Captured after pupil dilation, acquired with a Topcon TRC-50DX
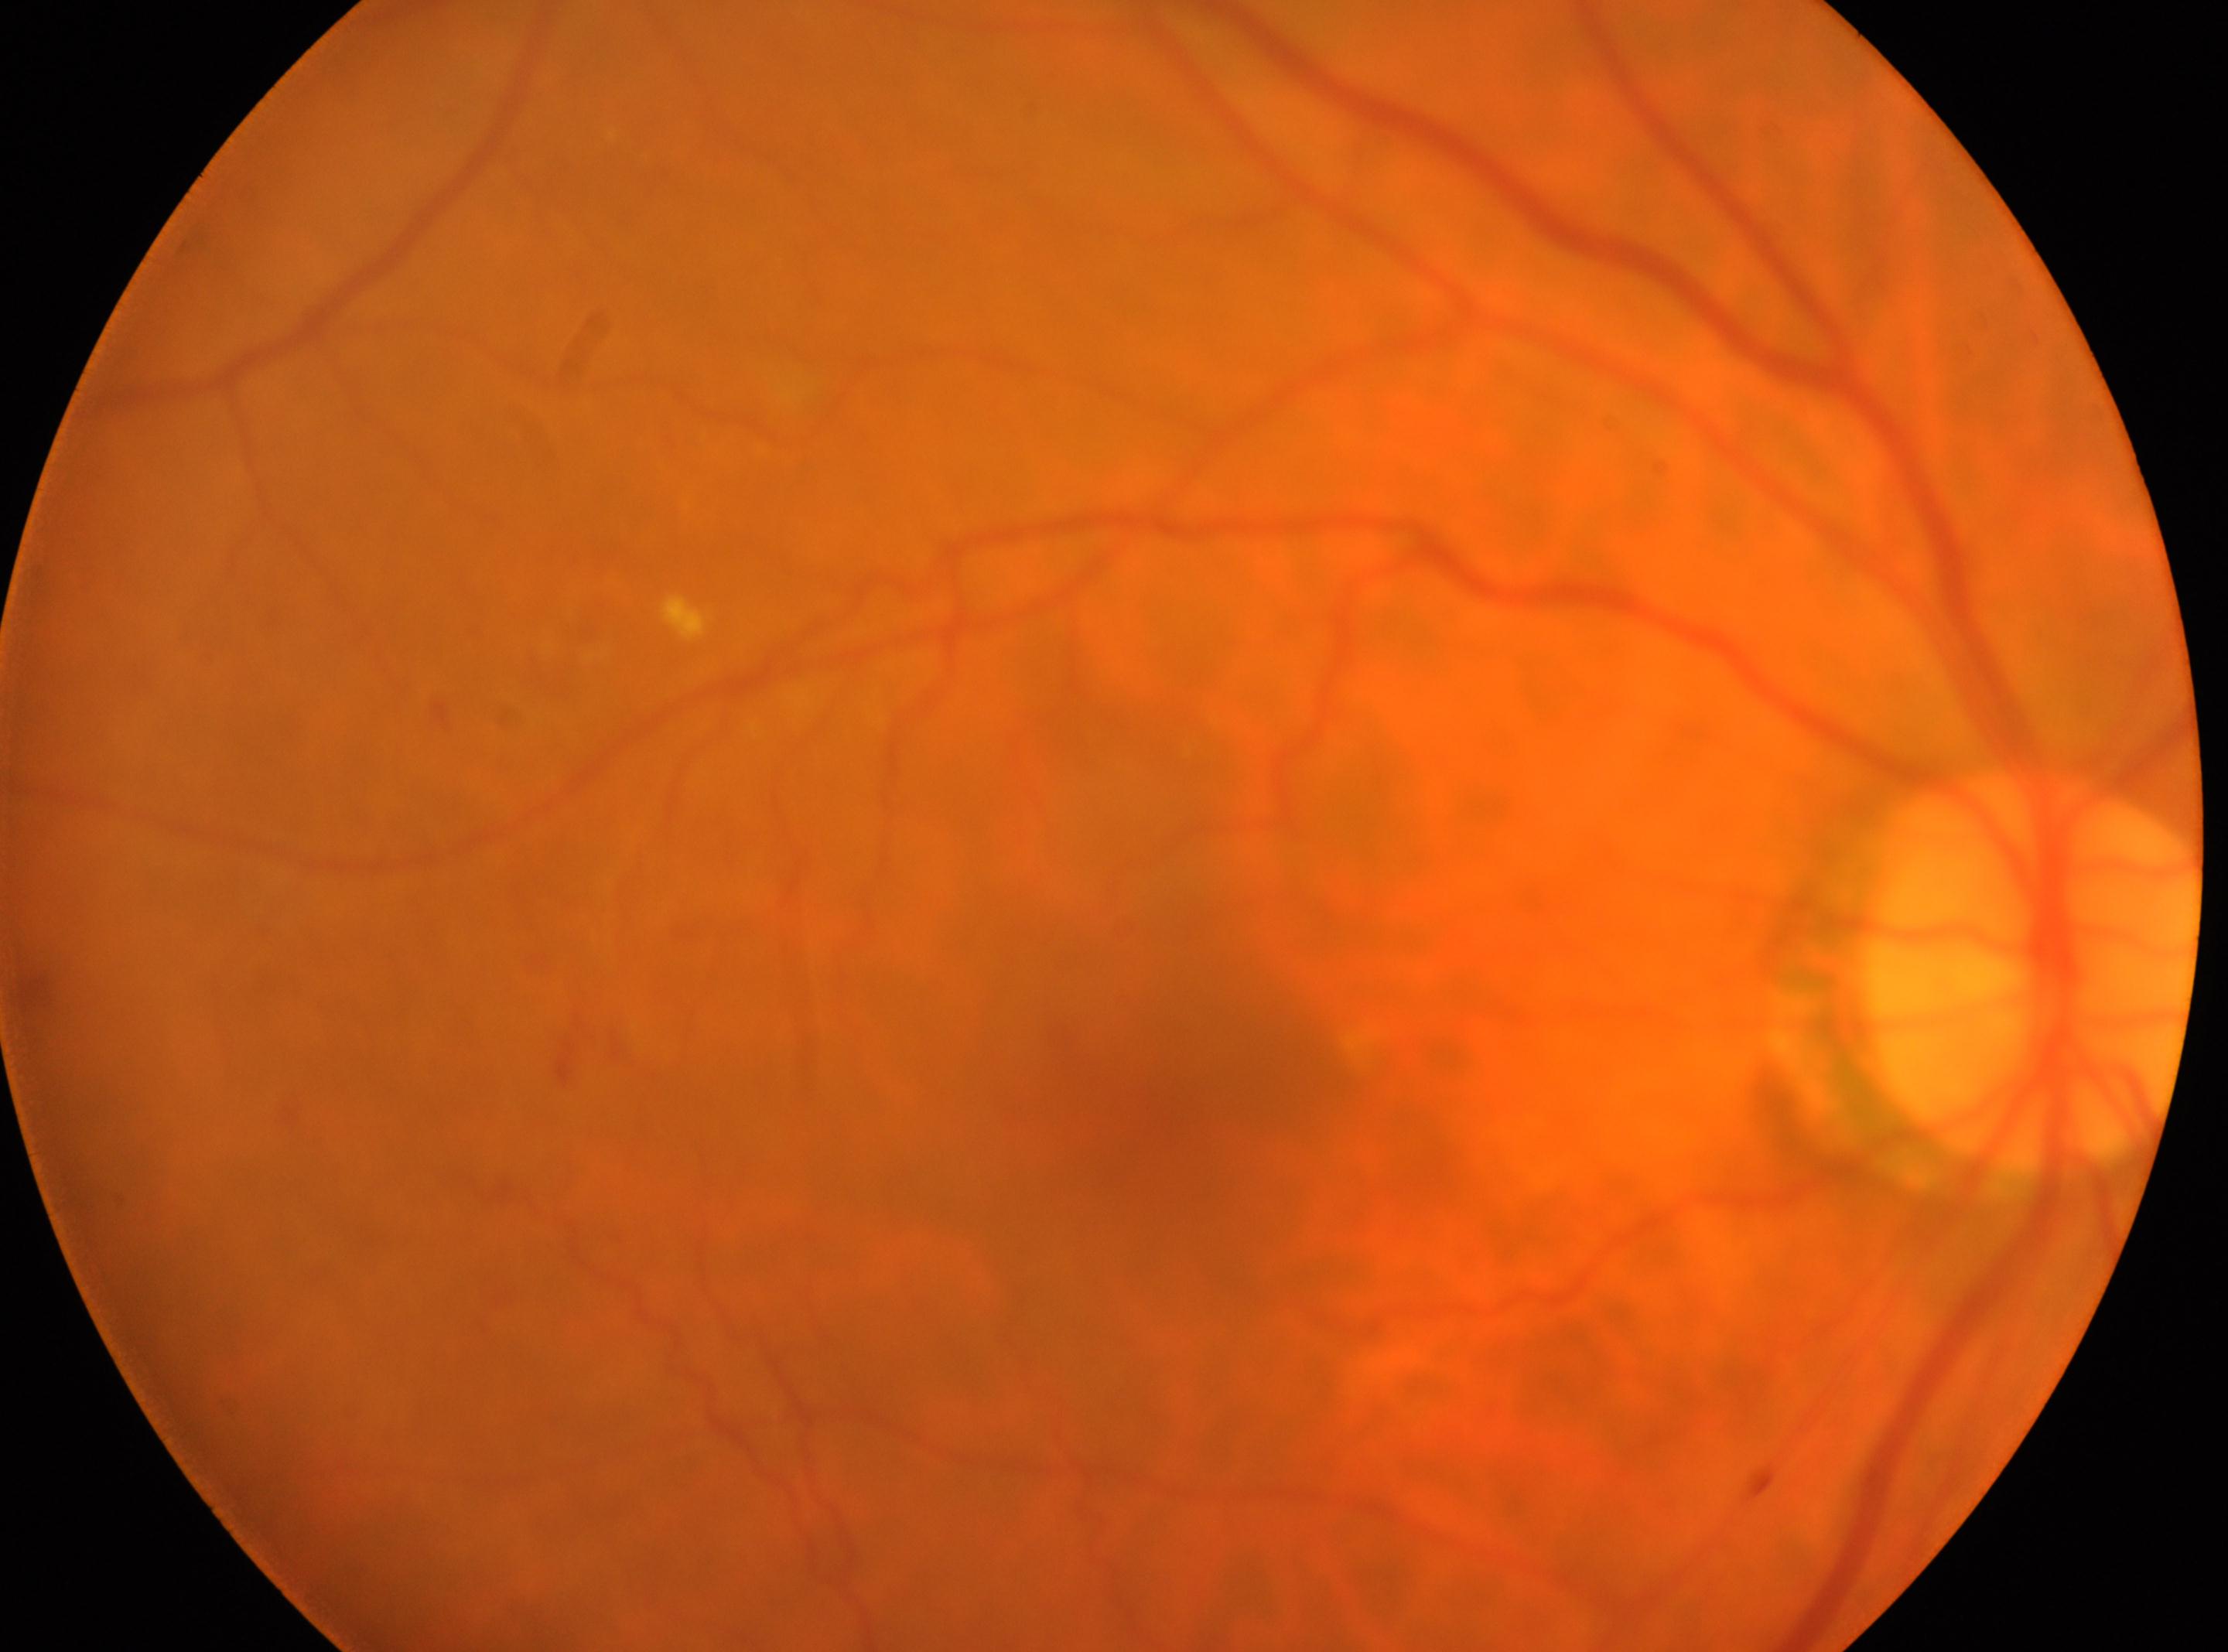 Findings:
– fovea center: (x: 1171, y: 1129)
– optic nerve head: (x: 2033, y: 974)
– laterality: right eye
– diabetic retinopathy (DR): 2